Without pupil dilation · 848x848px · modified Davis classification · NIDEK AFC-230 fundus camera:
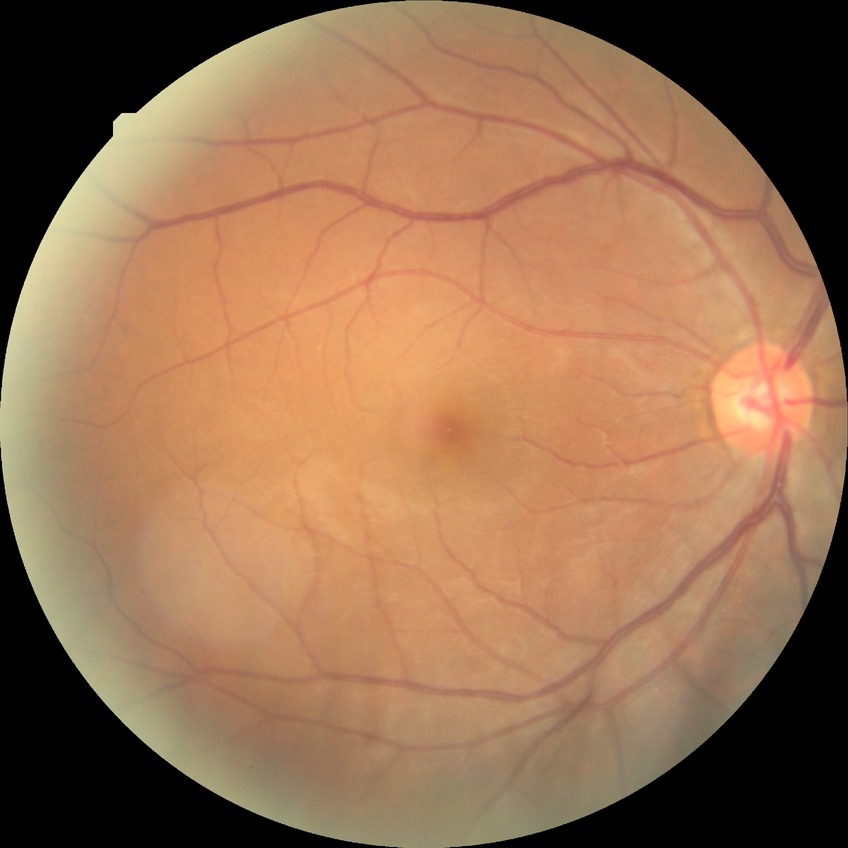 Diabetic retinopathy (DR) is NDR (no diabetic retinopathy).